Wide-field contact fundus photograph of an infant
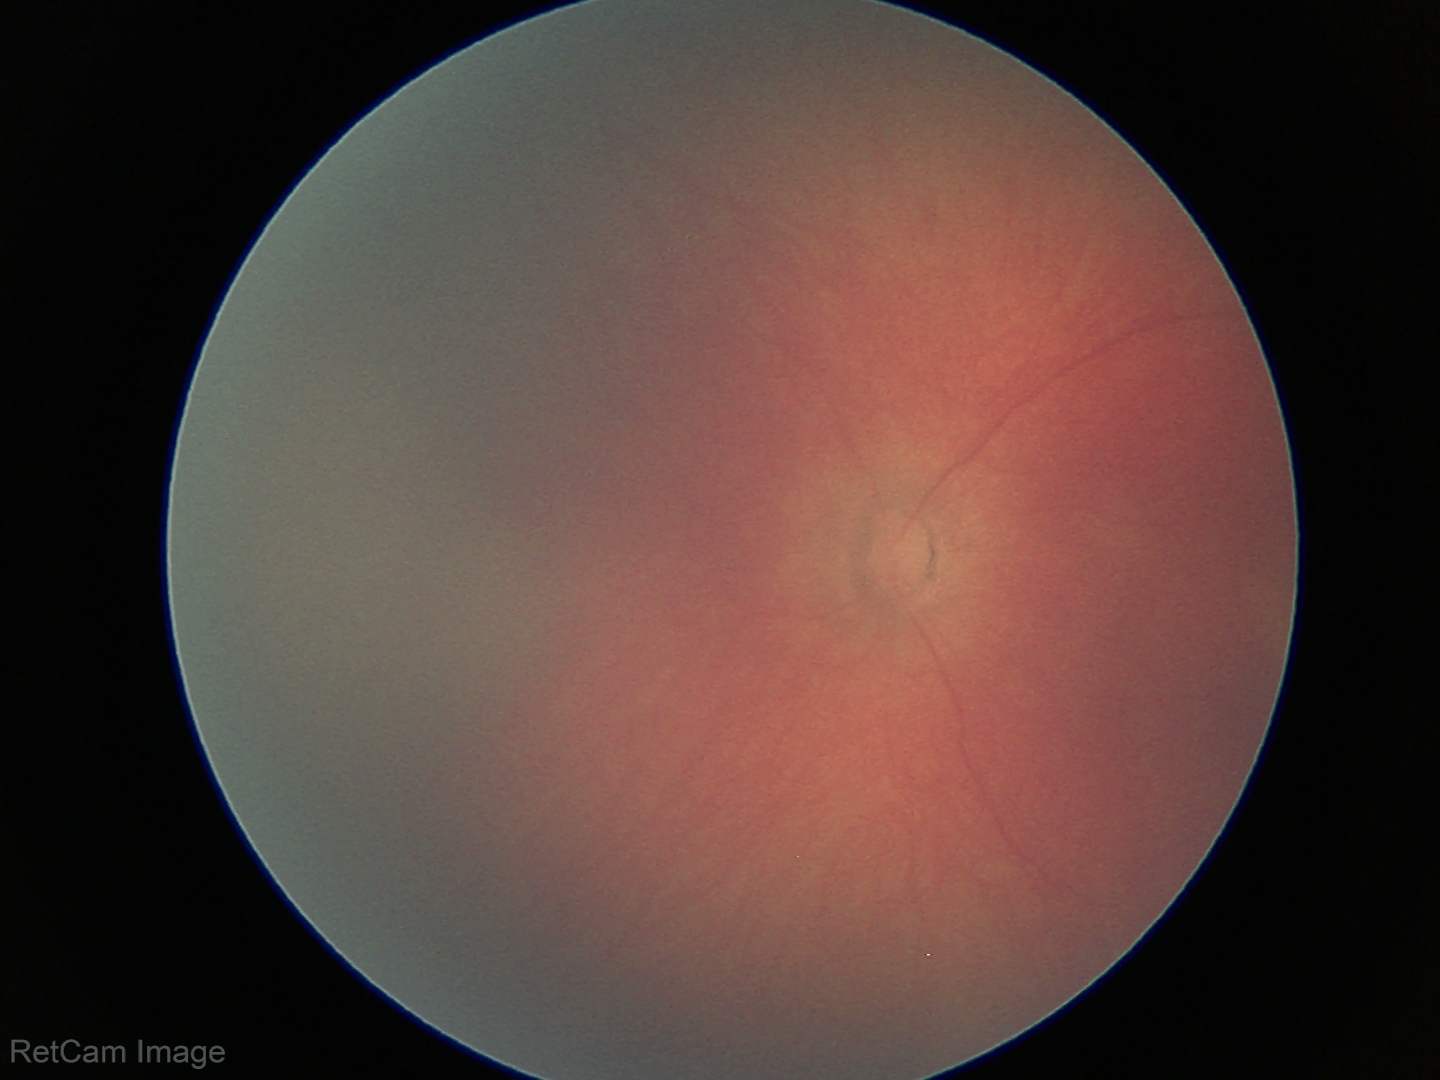 No retinal pathology identified on screening.